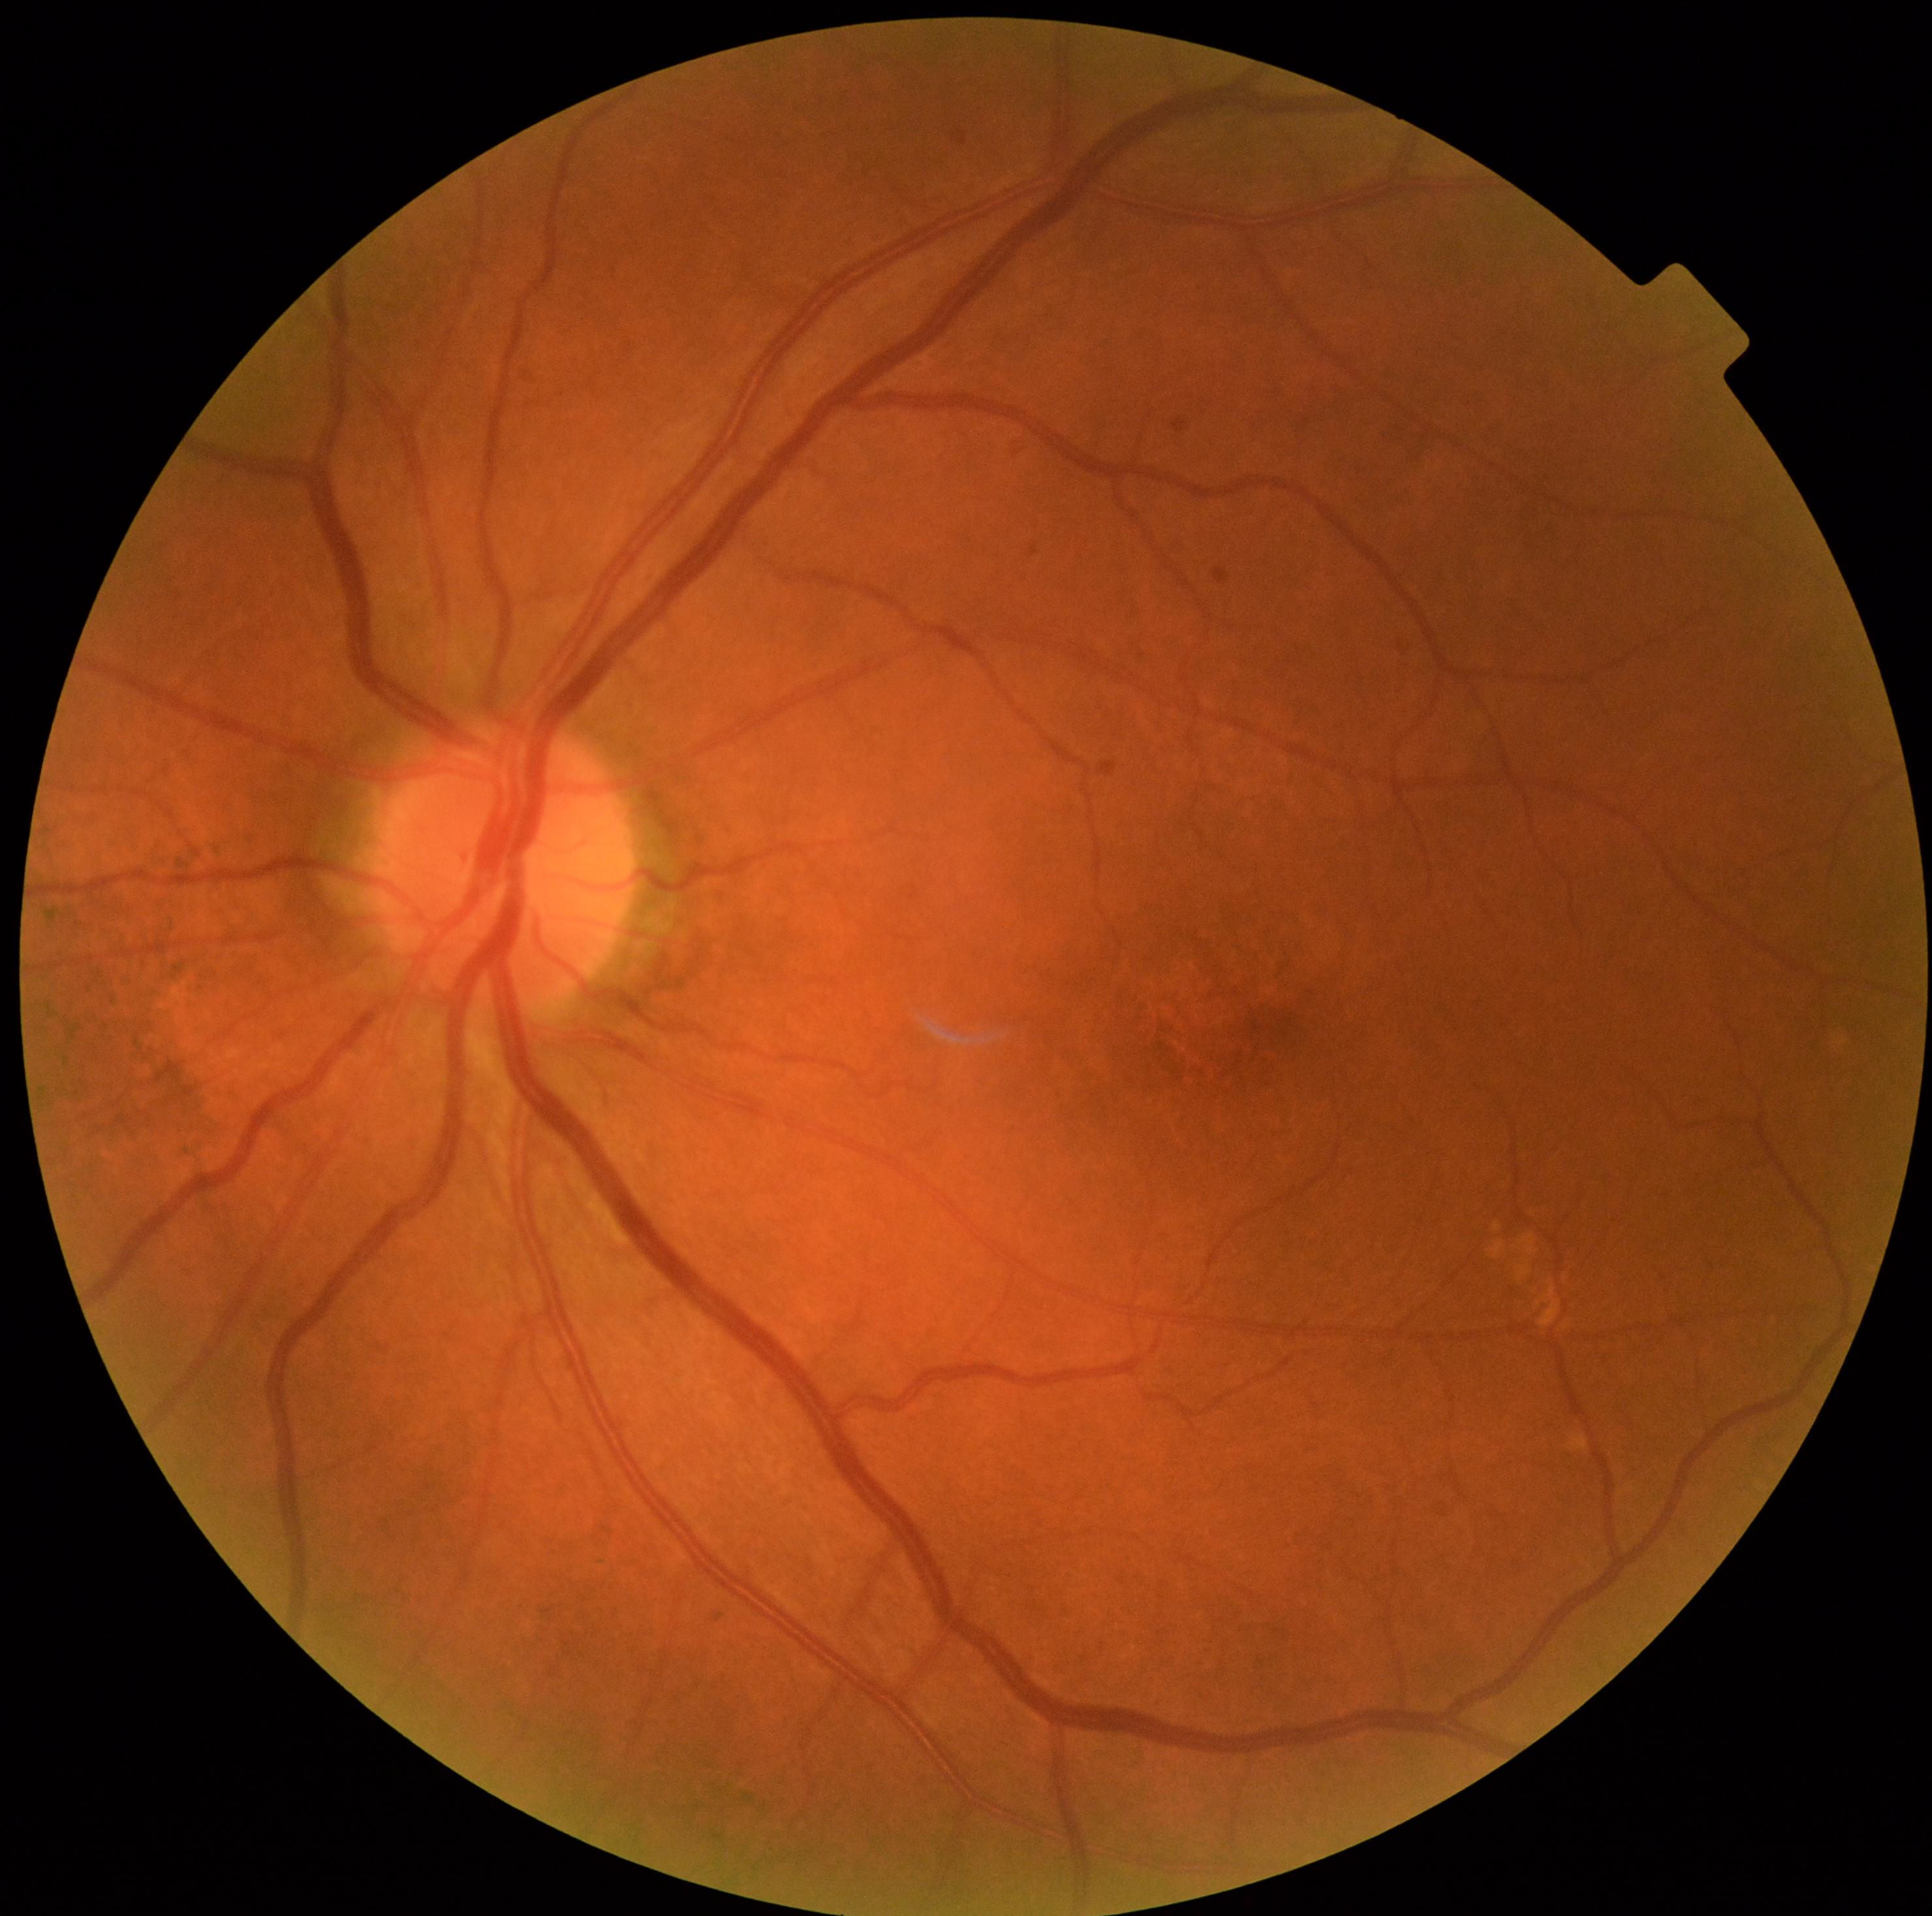 DR=0/4.